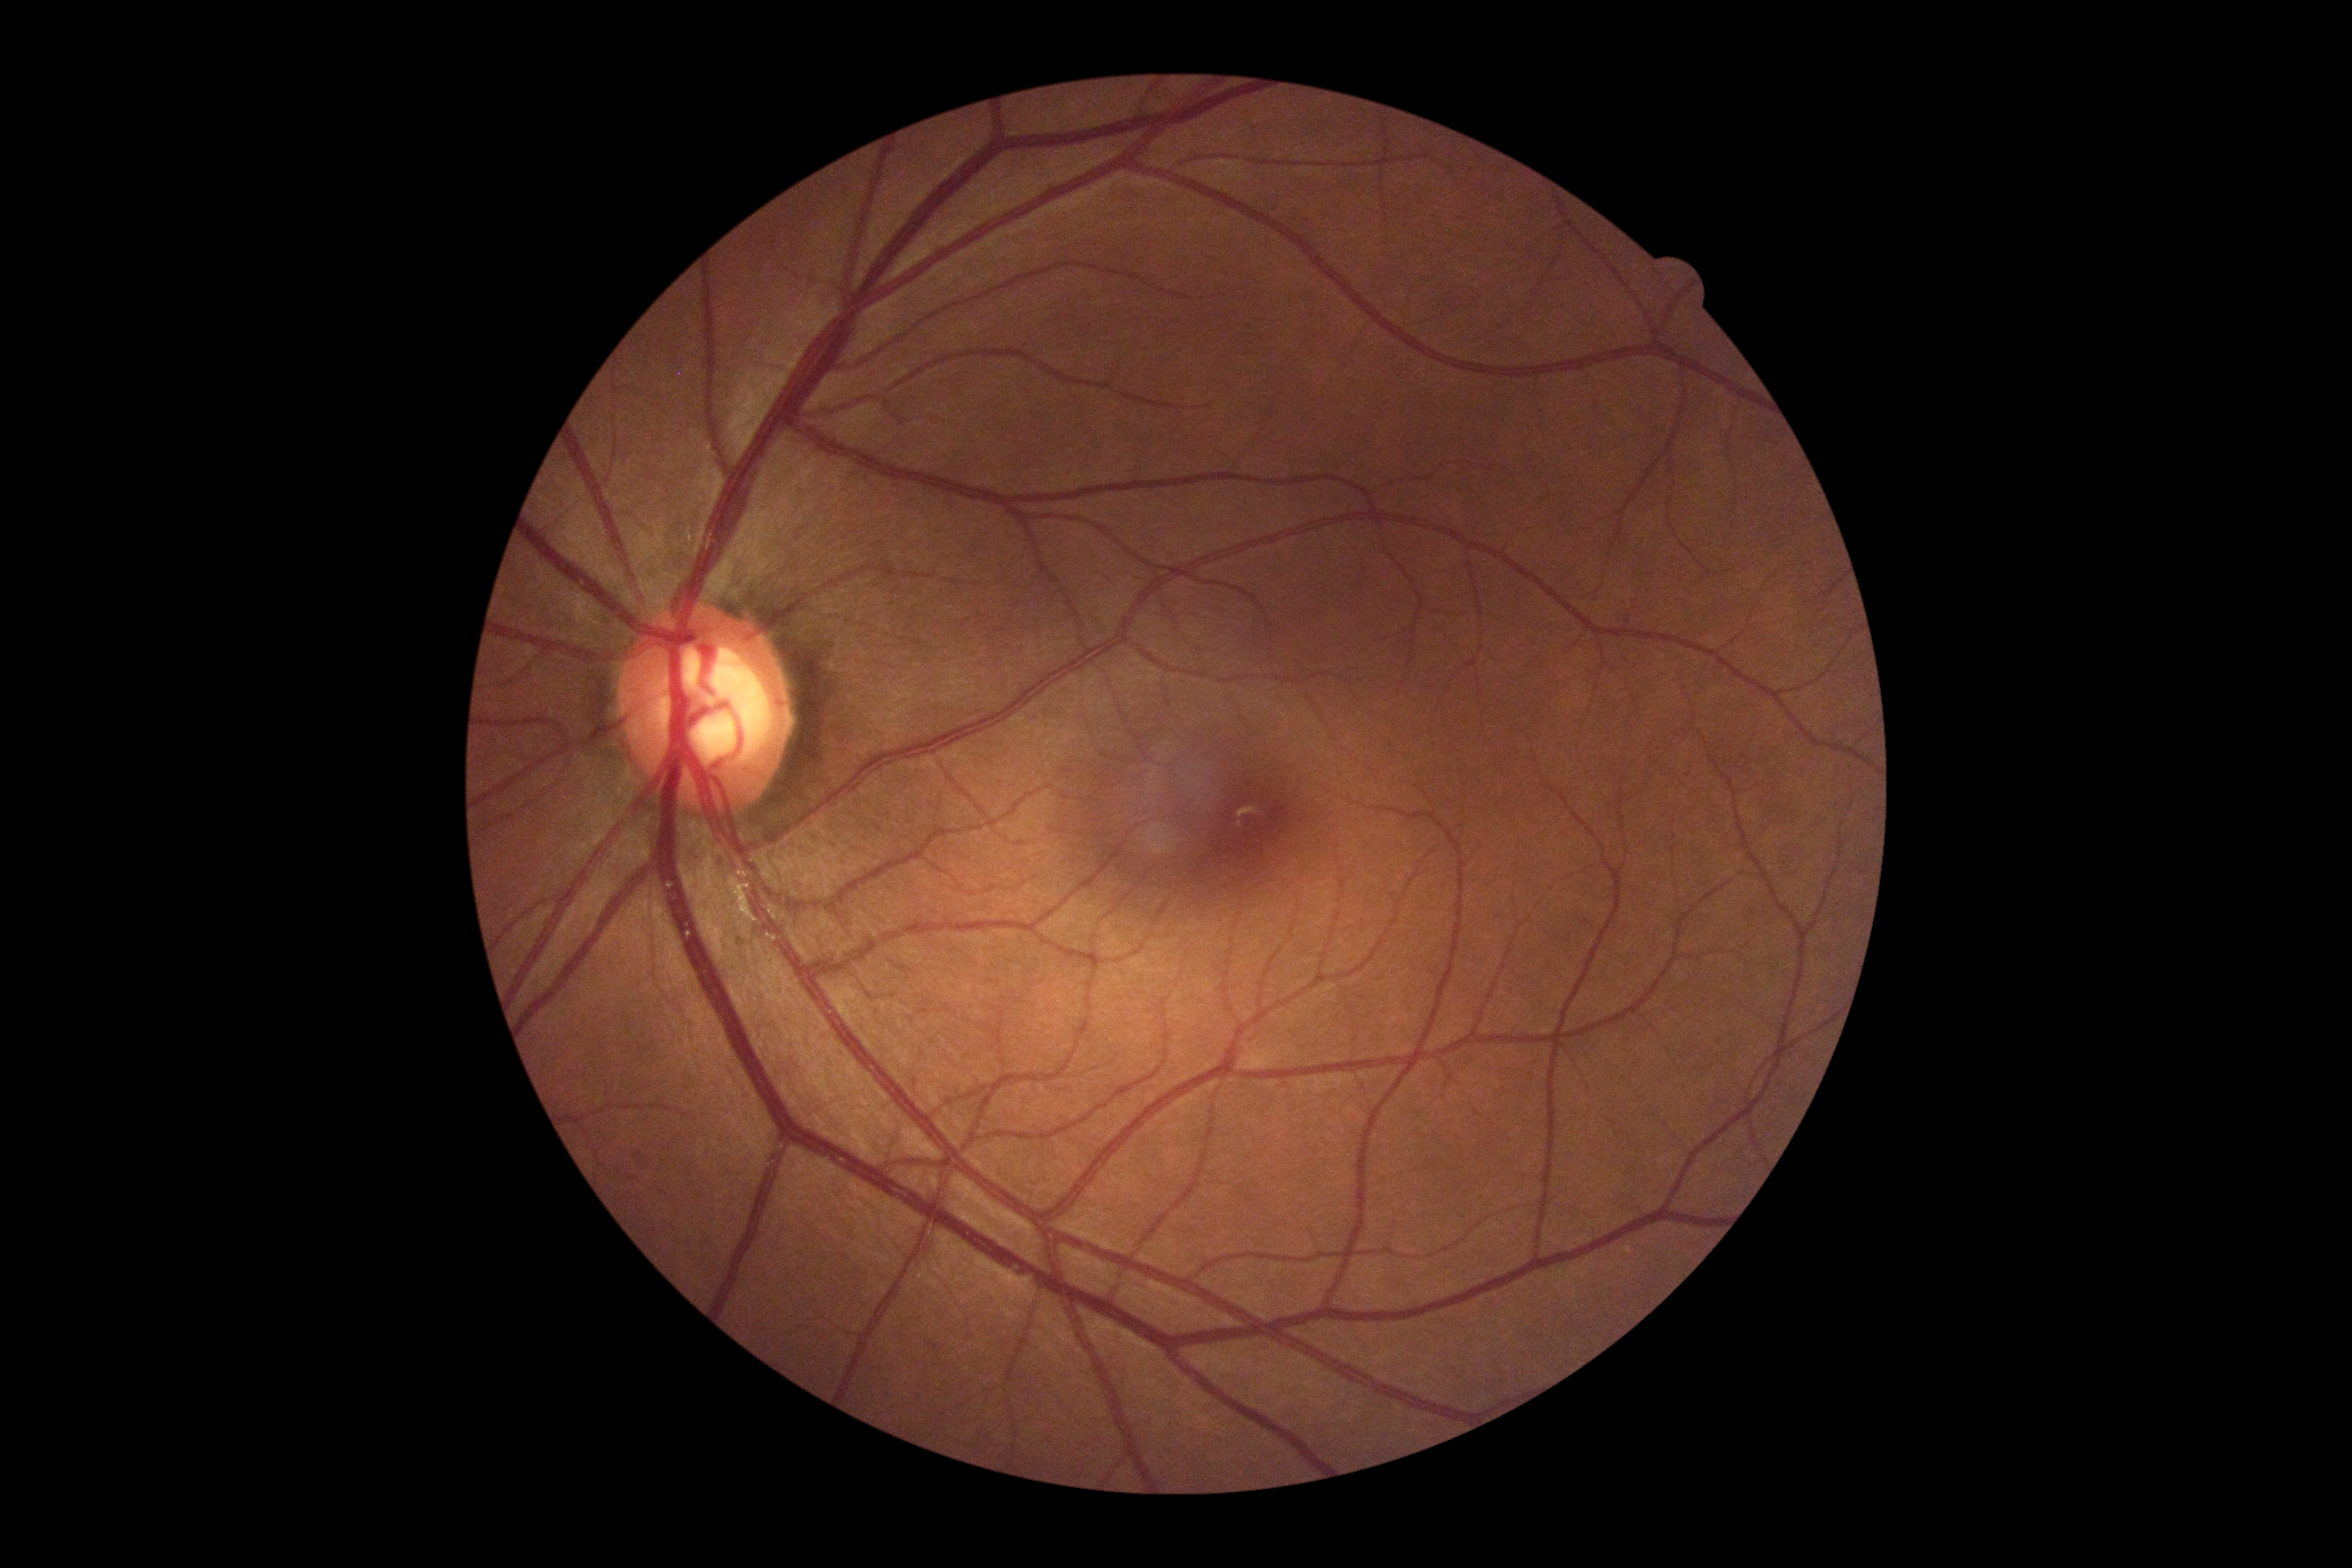

DR grade is 0.